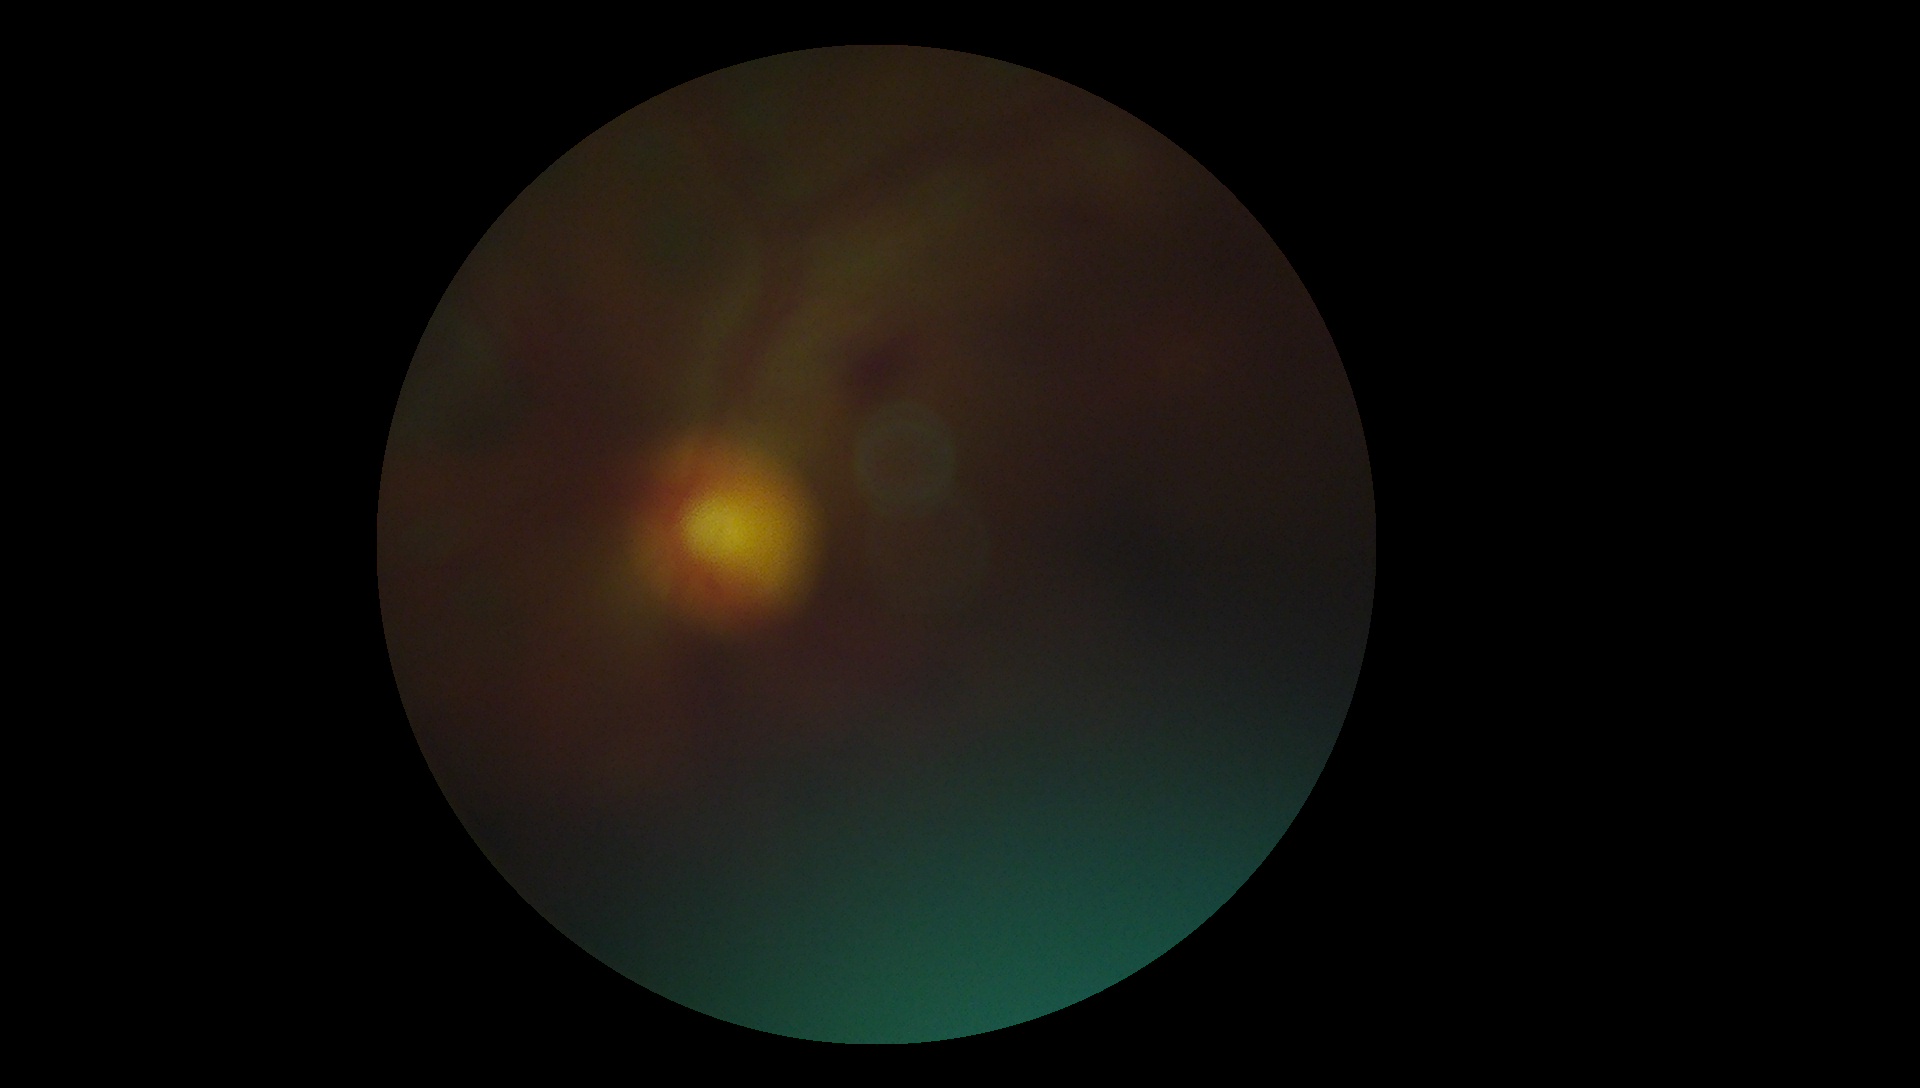 Diabetic retinopathy severity is ungradable due to poor image quality.